1659x2212px — 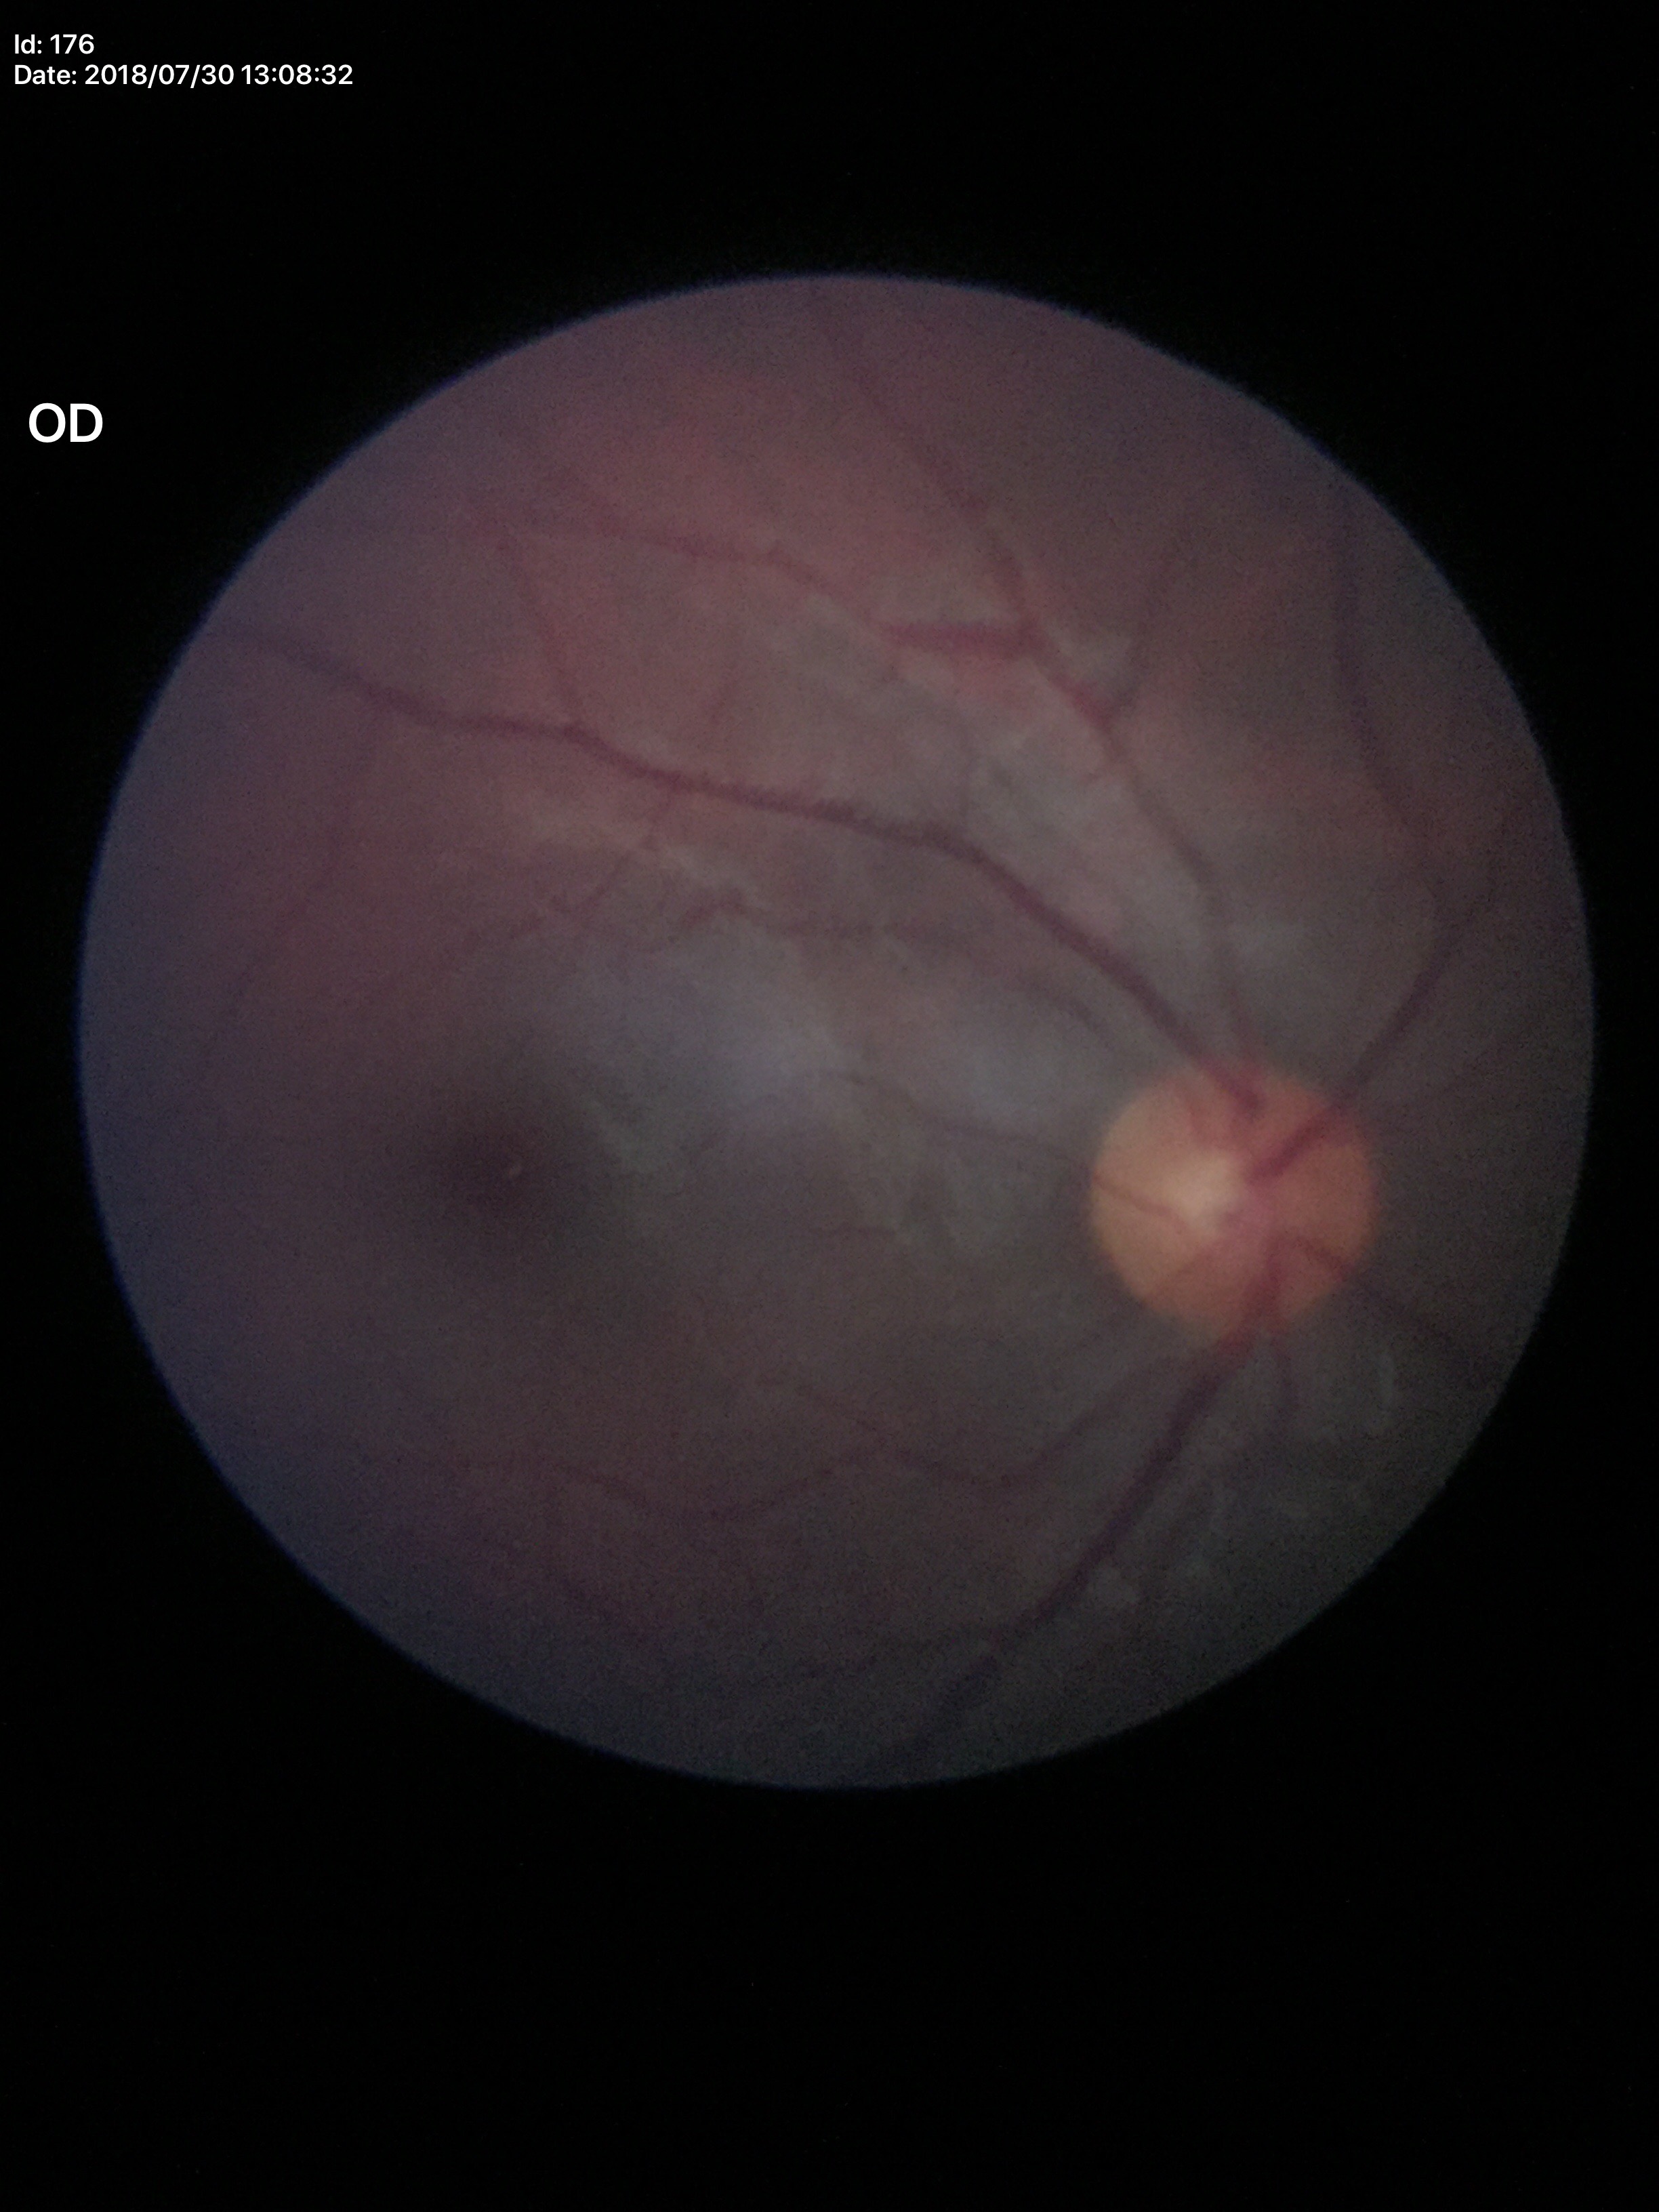 Annotations:
• Glaucoma impression · negative
• vertical cup-to-disc ratio · 0.43